Without pupil dilation. 848 x 848 pixels — 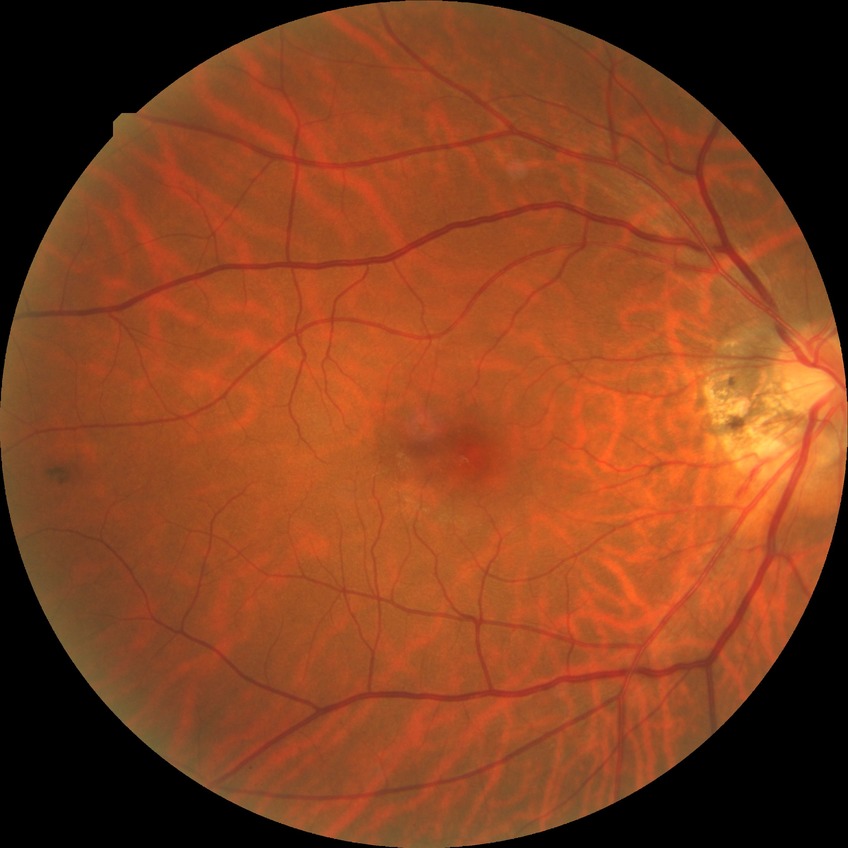 {
  "davis_grade": "no diabetic retinopathy"
}